Wide-field fundus photograph of an infant.
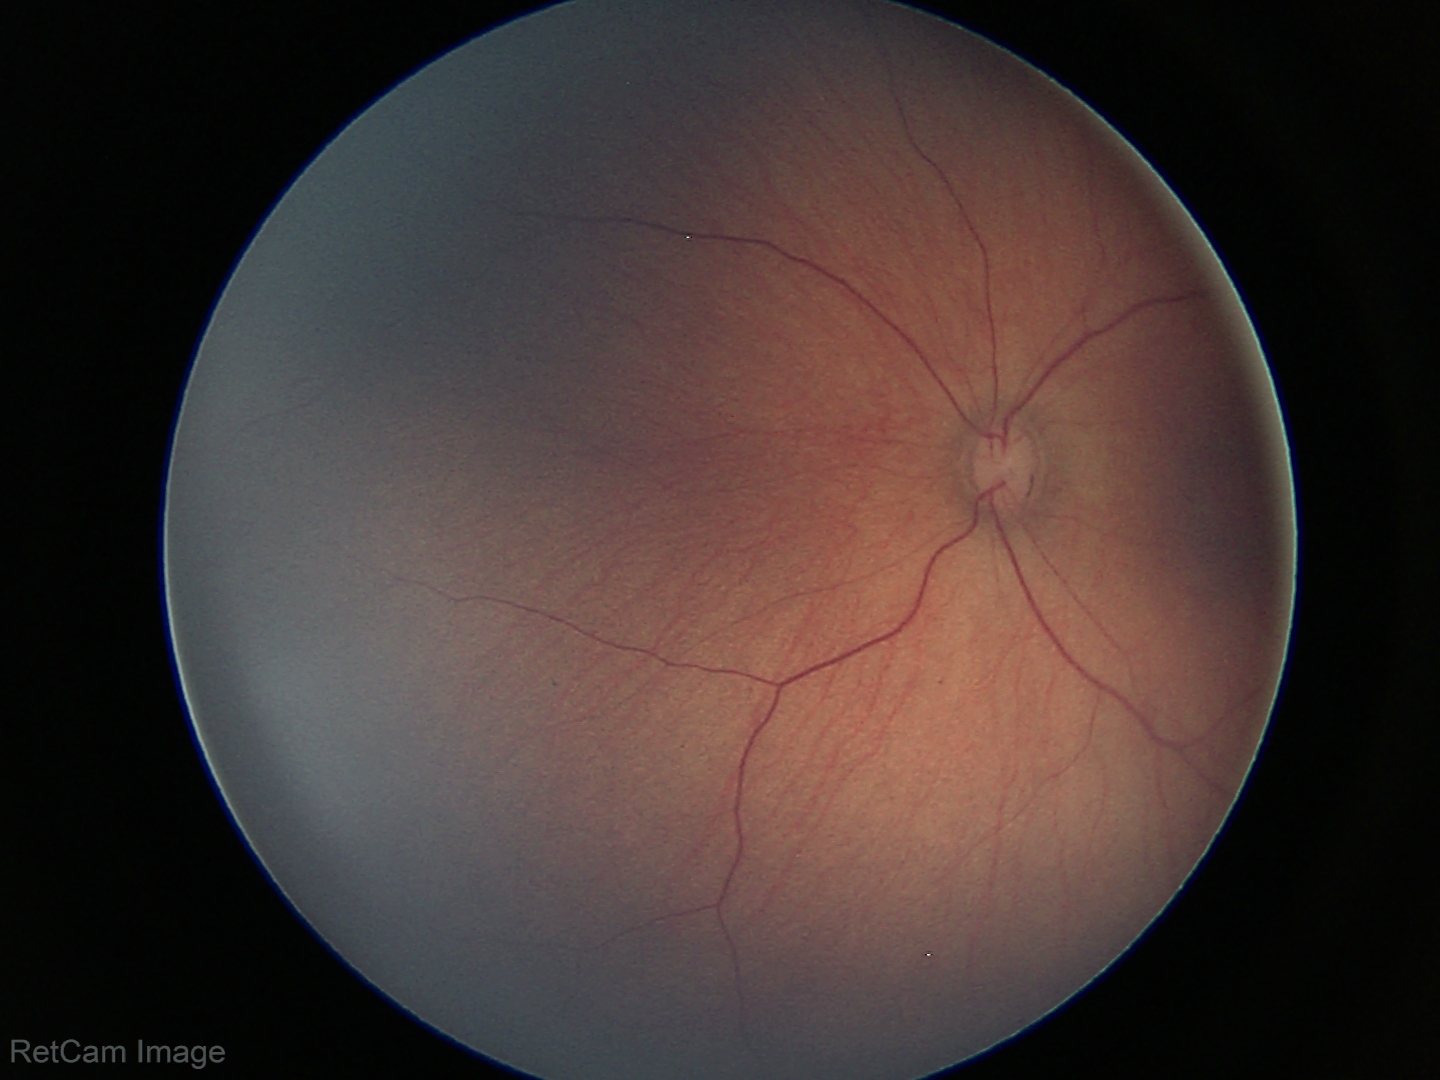
Physiological retinal appearance for postconceptual age.